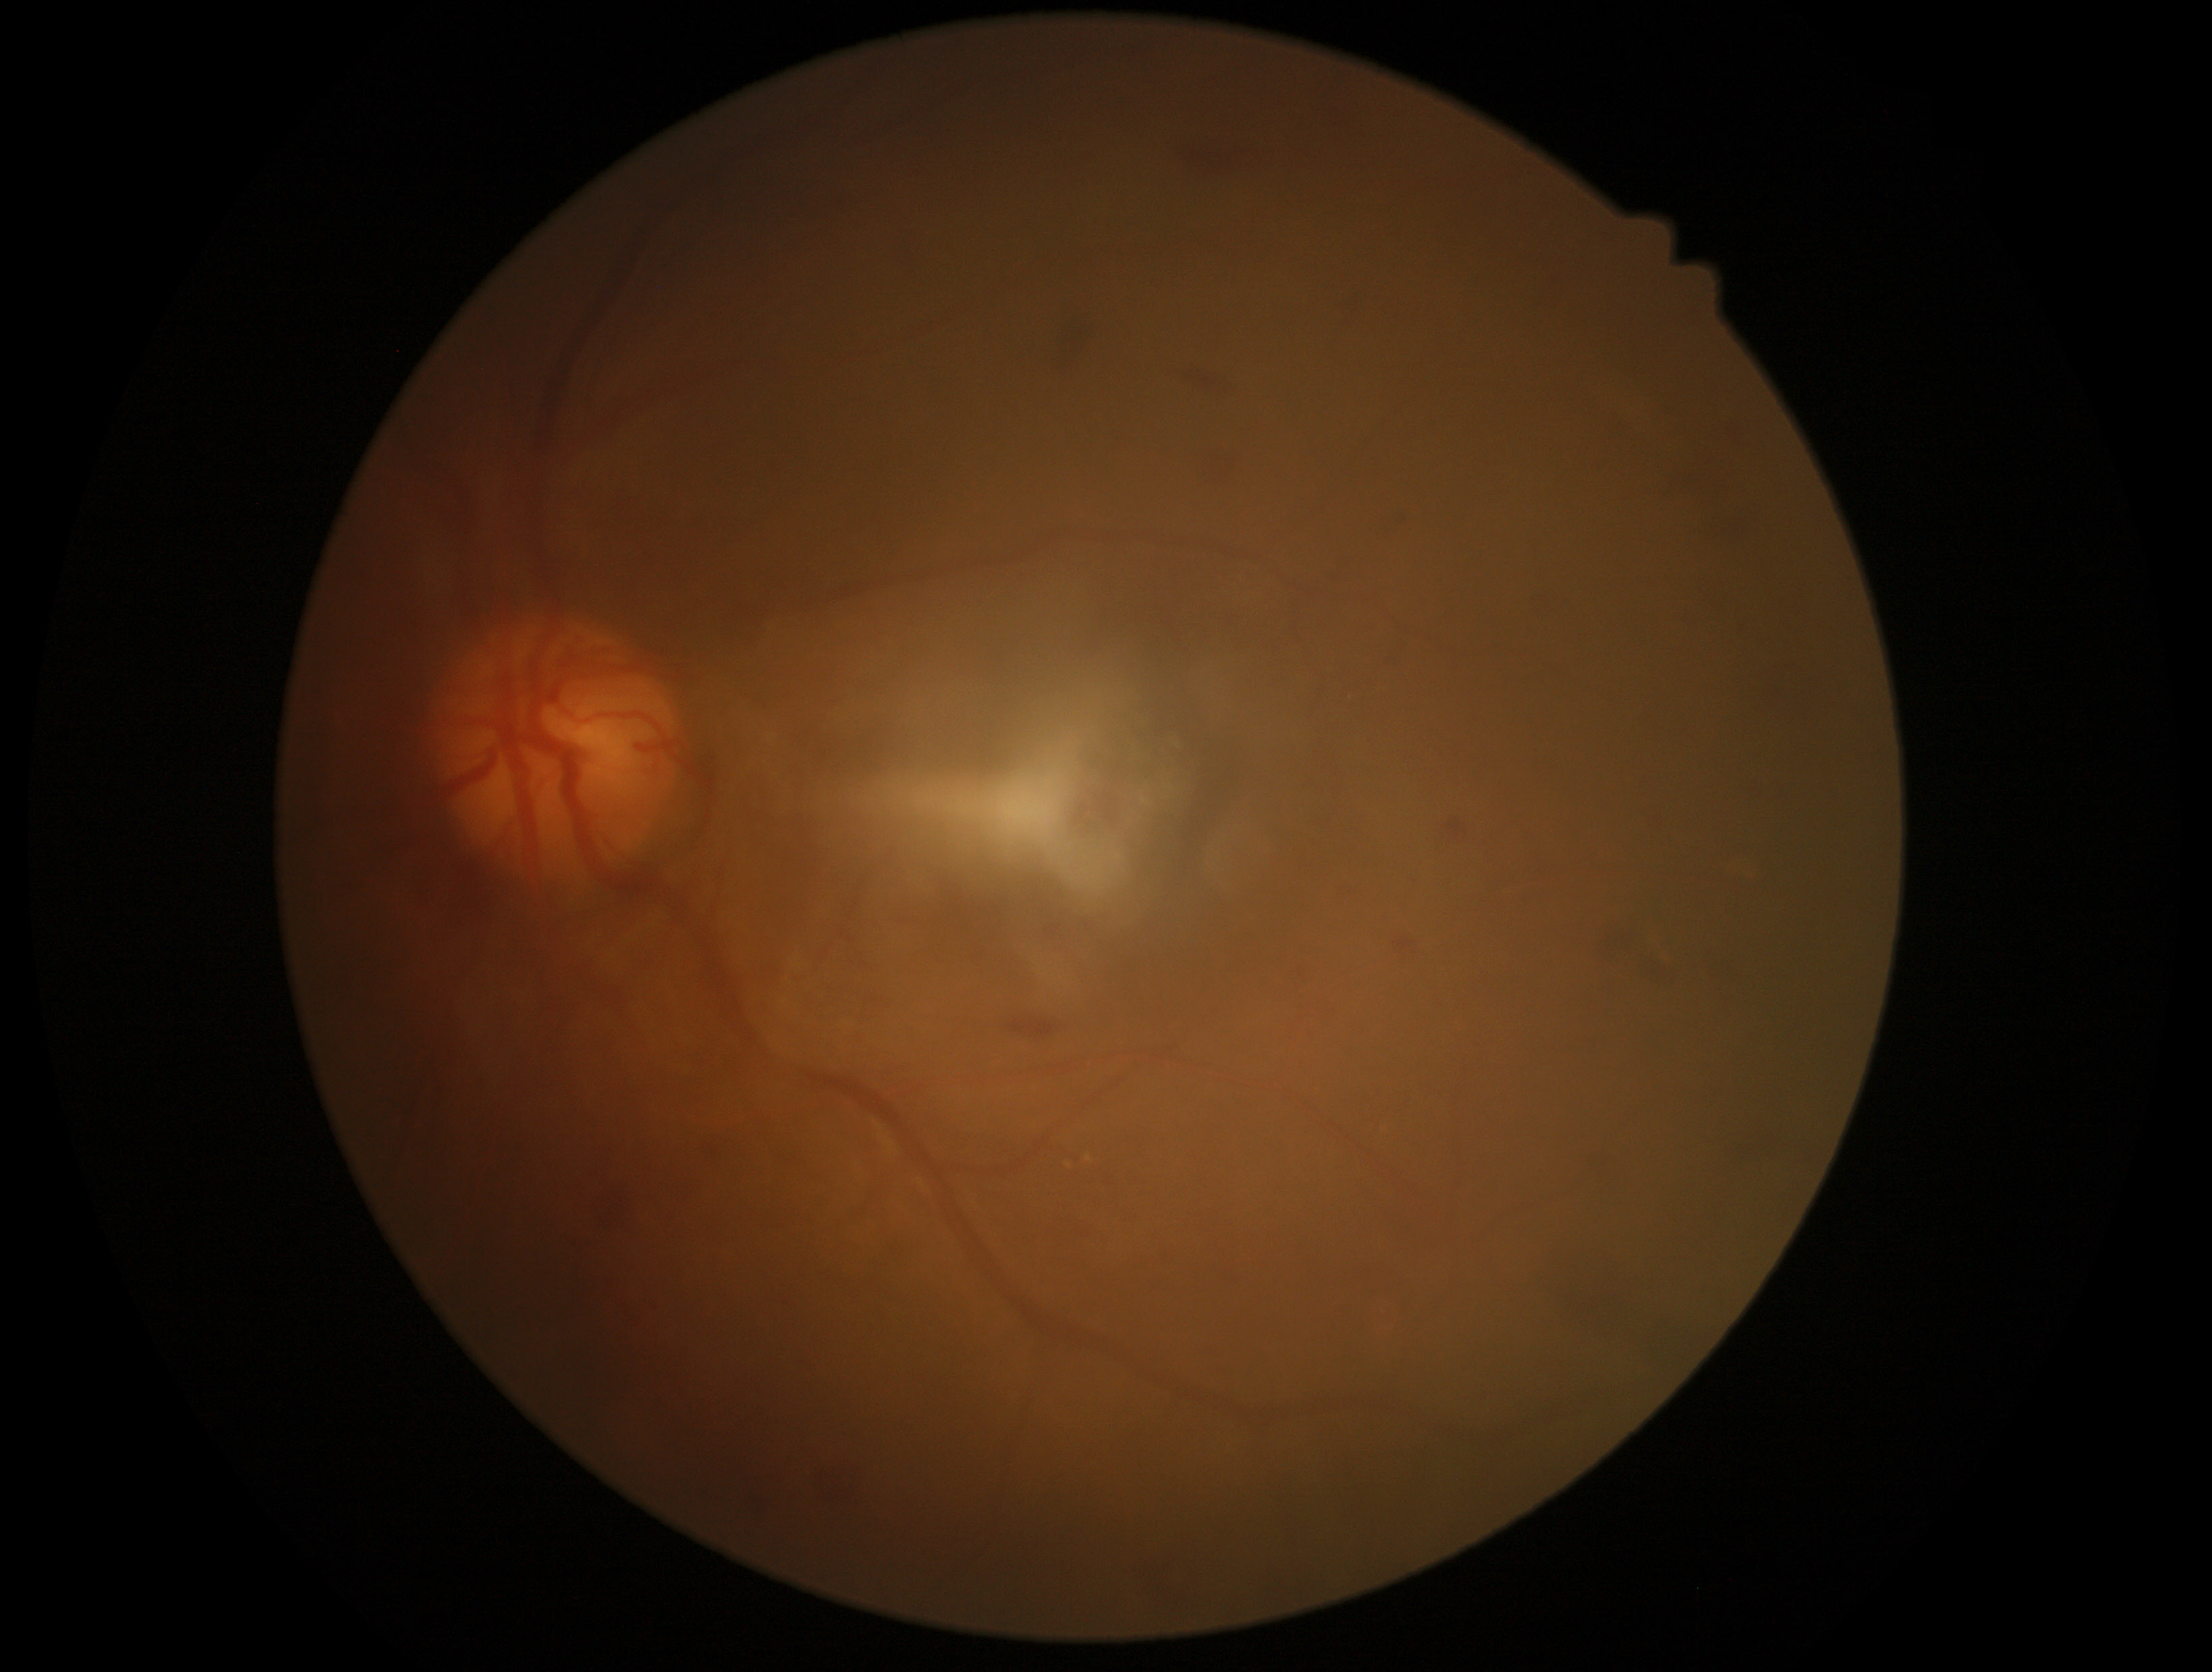 * diabetic retinopathy (DR): grade 2 (moderate NPDR)